FOV: 45 degrees; CFP; 2212x1659px
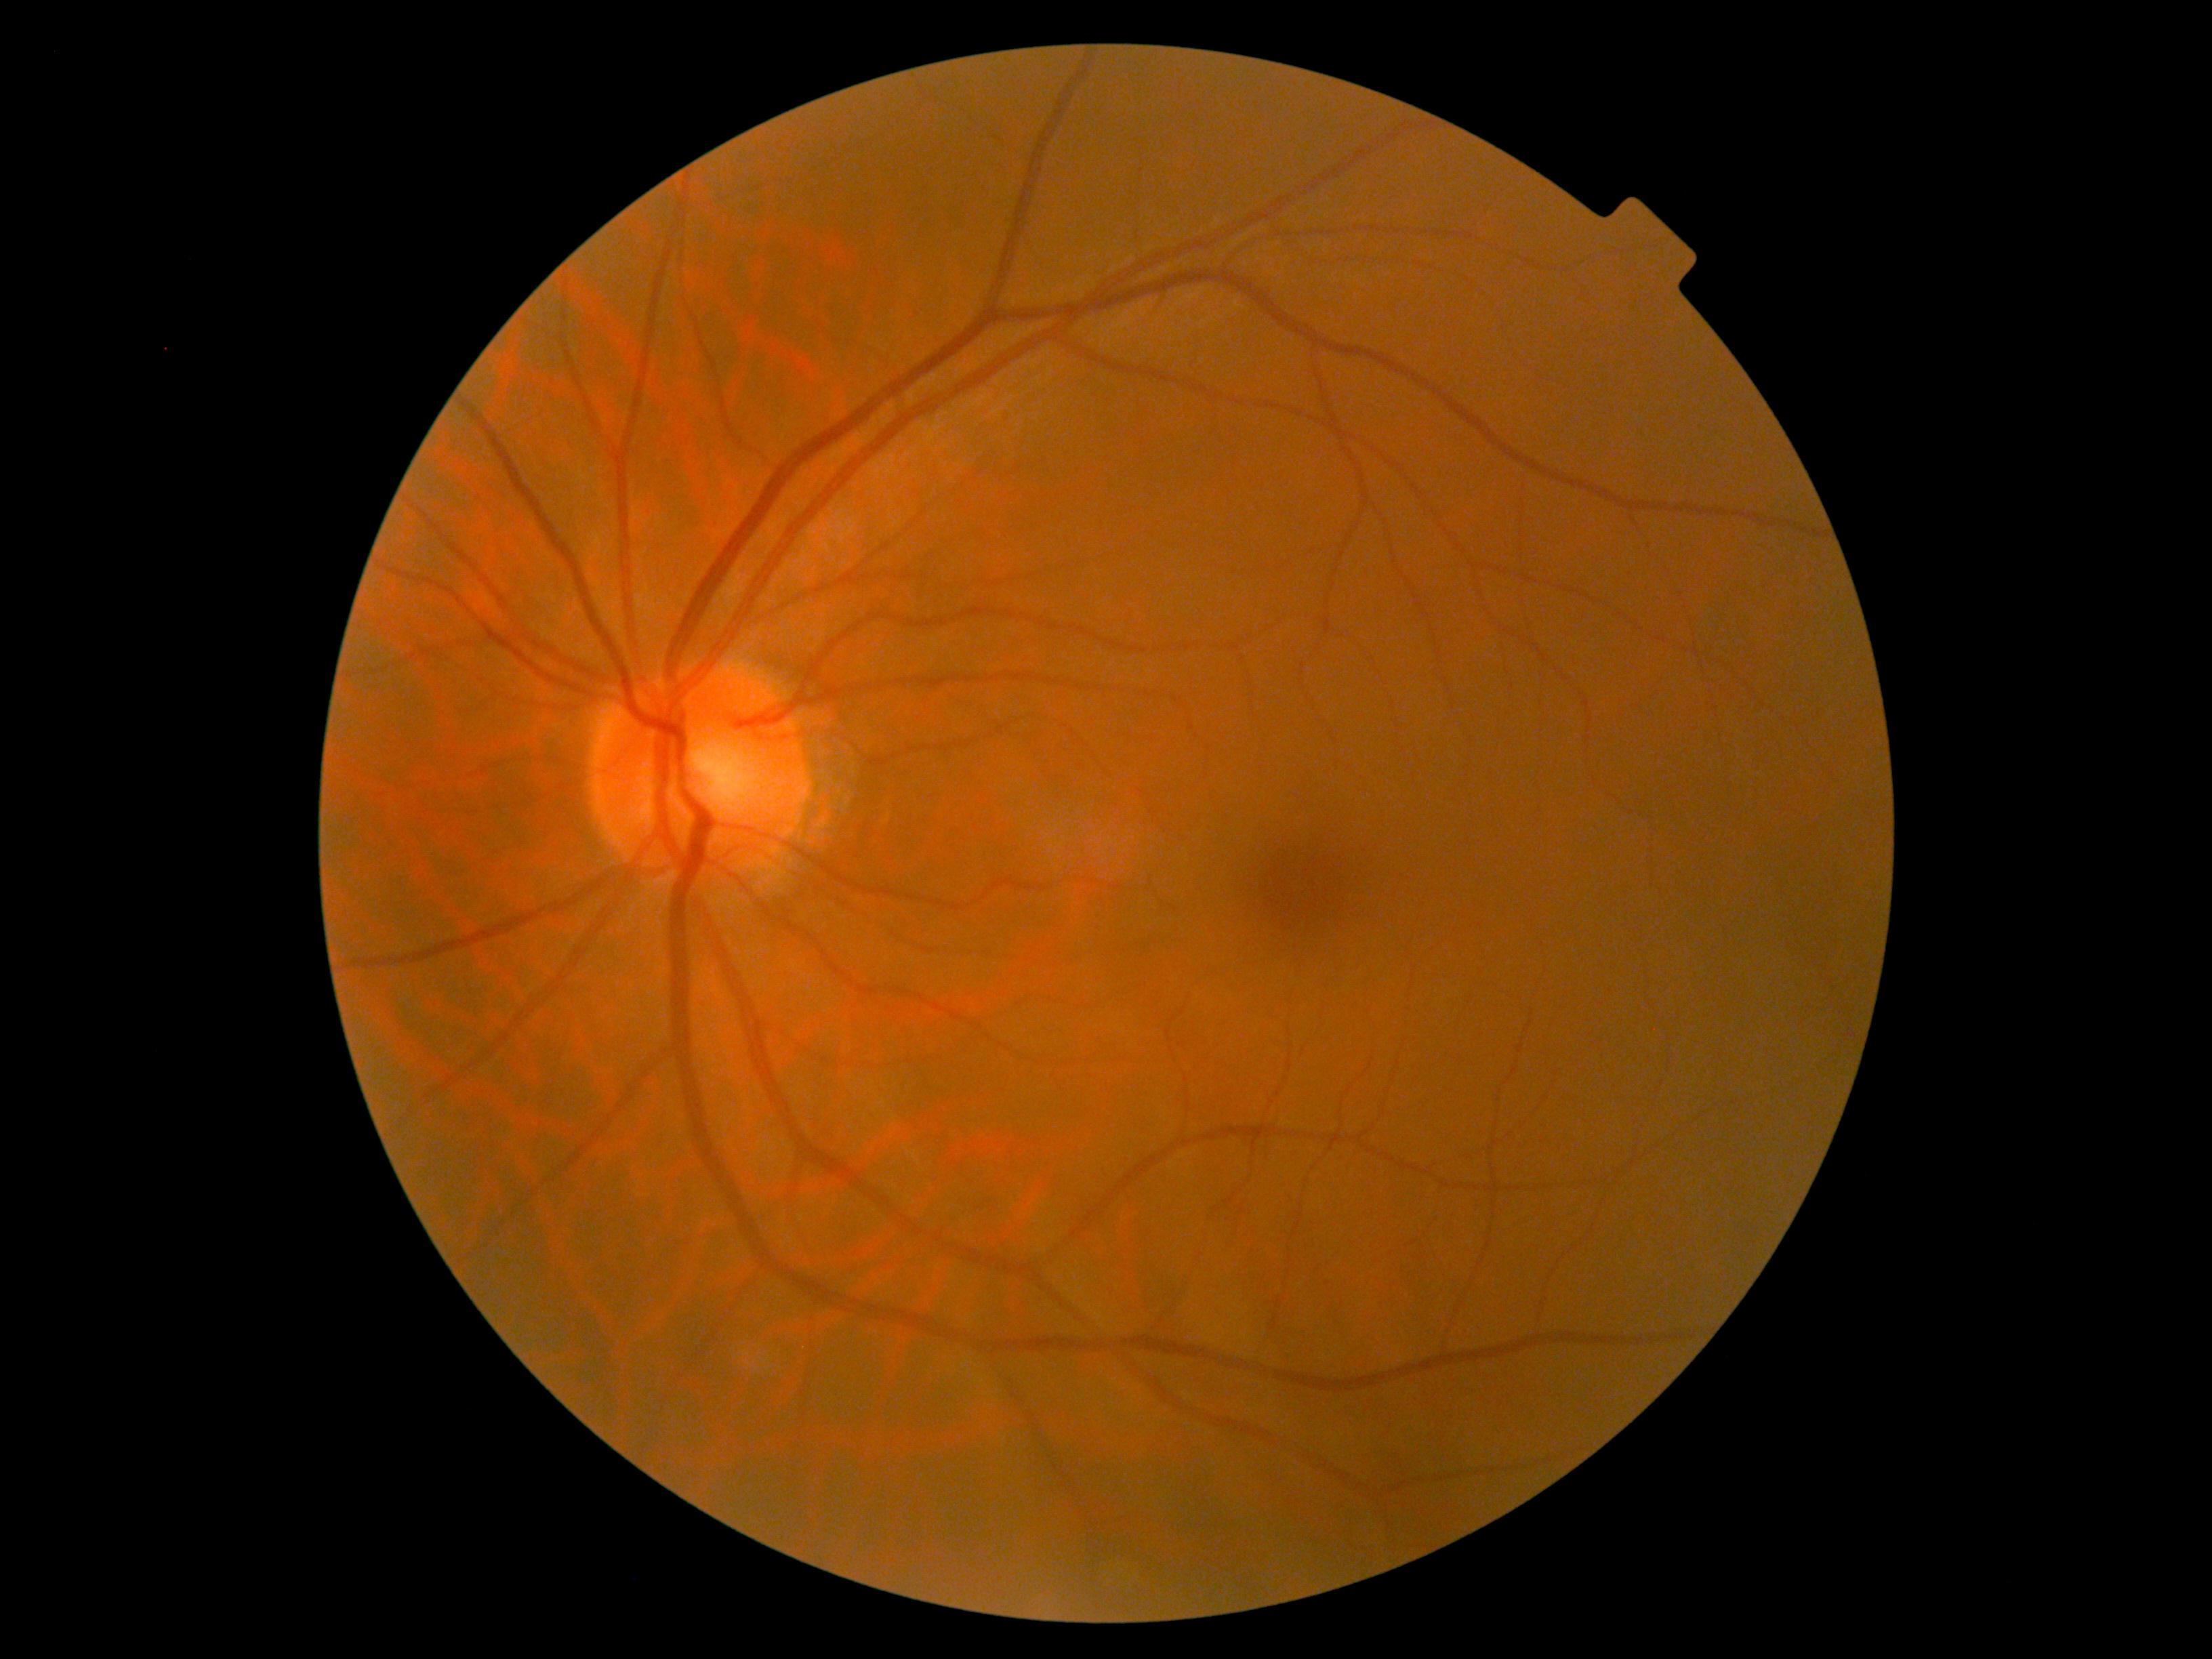 Retinopathy grade: 0/4 — no visible signs of diabetic retinopathy.